Pediatric wide-field fundus photograph · 640 by 480 pixels: 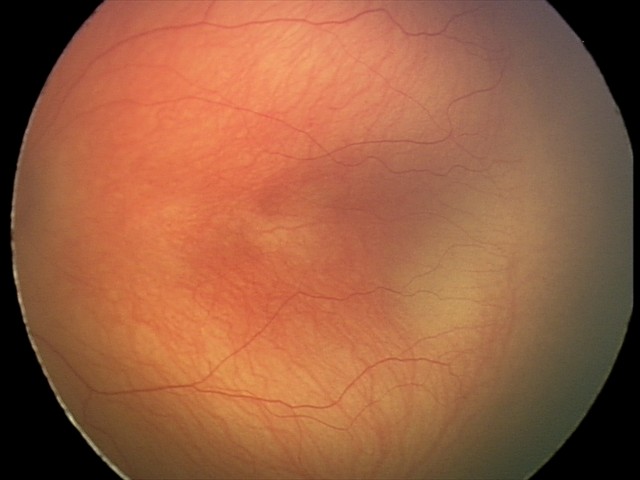

Screening series with retinopathy of prematurity (ROP) stage 2.
No plus disease.